1240 by 1240 pixels; pediatric wide-field fundus photograph — 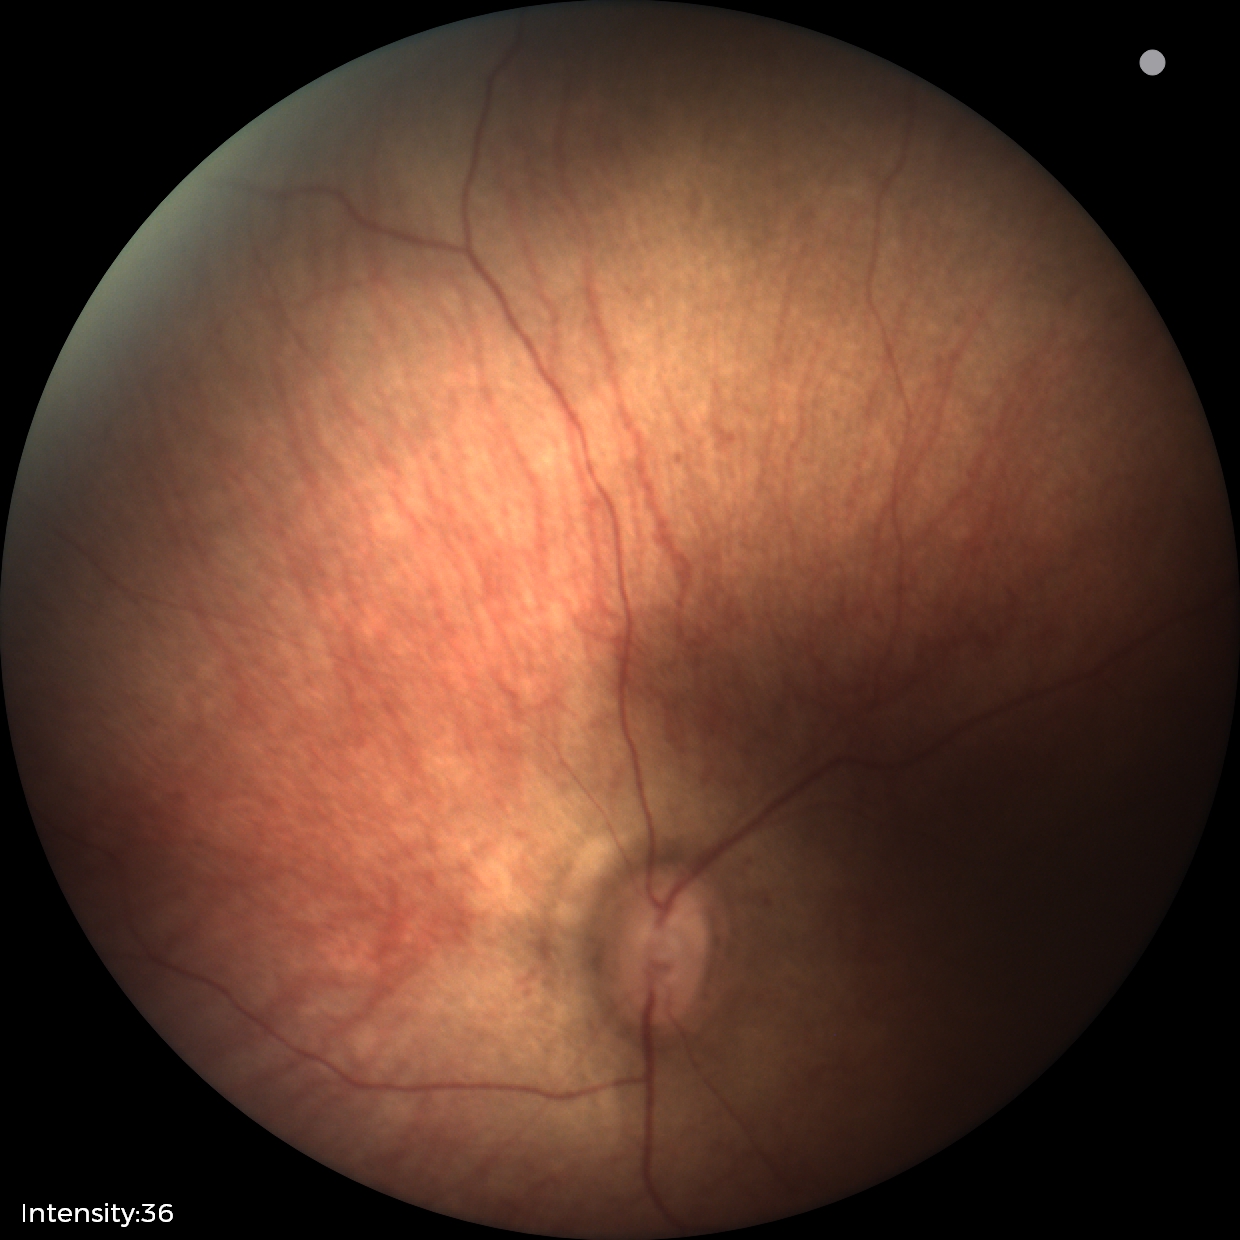
Examination with physiological retinal findings.